Ultra-widefield fundus photograph.
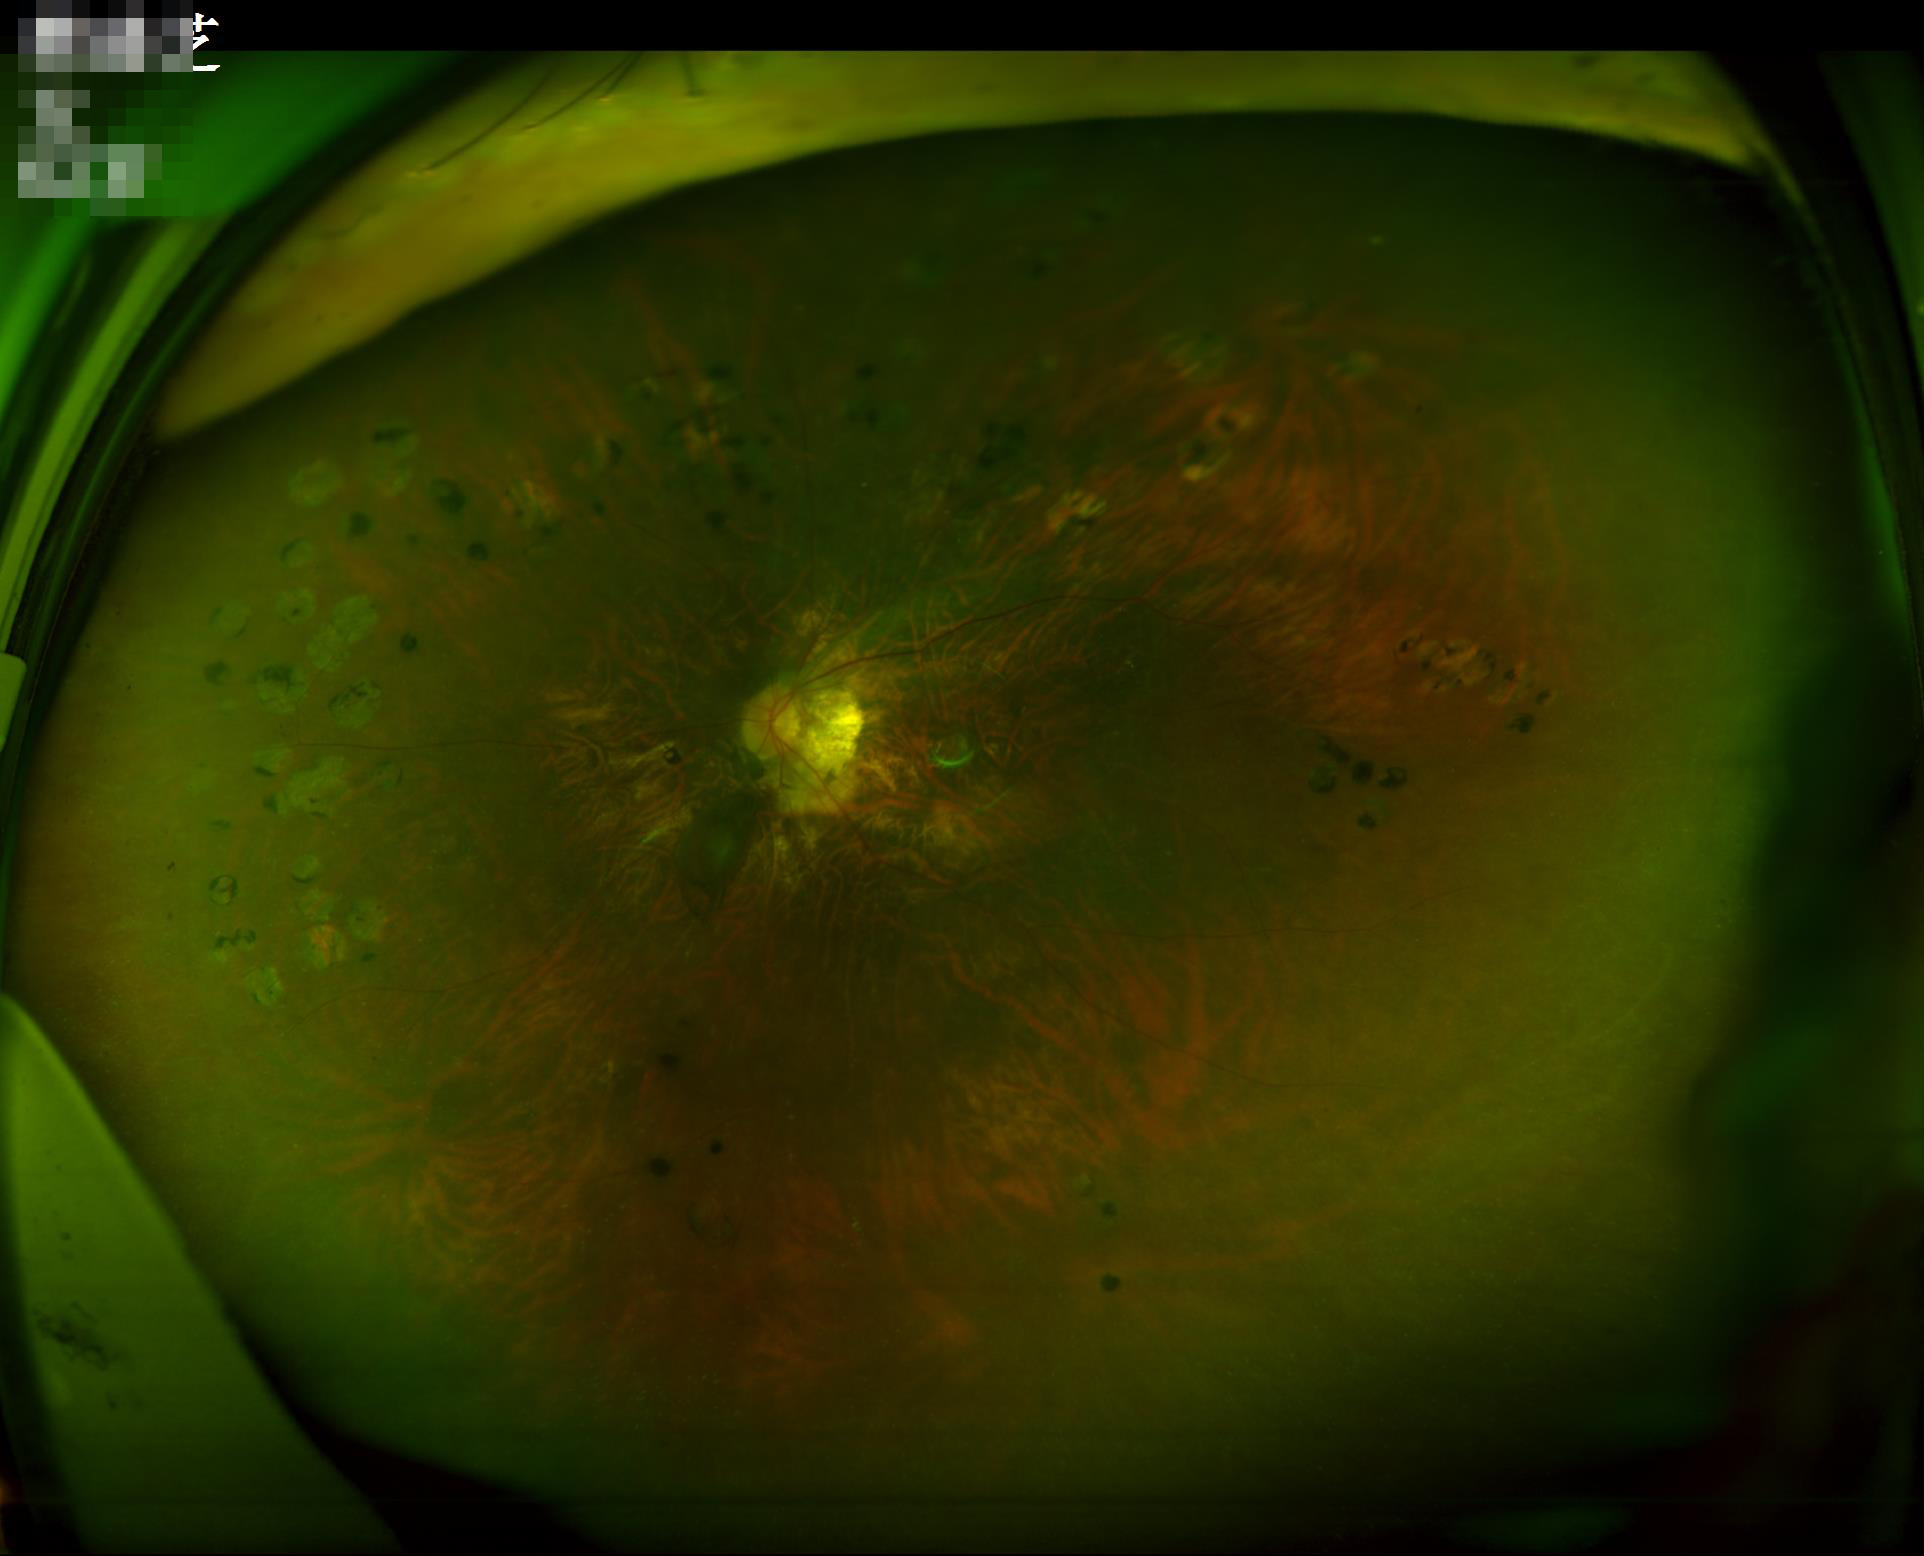 Image quality is suboptimal. Out of focus; structures are indistinct. Illumination and color are suboptimal. Poor dynamic range.